Dilated-pupil acquisition
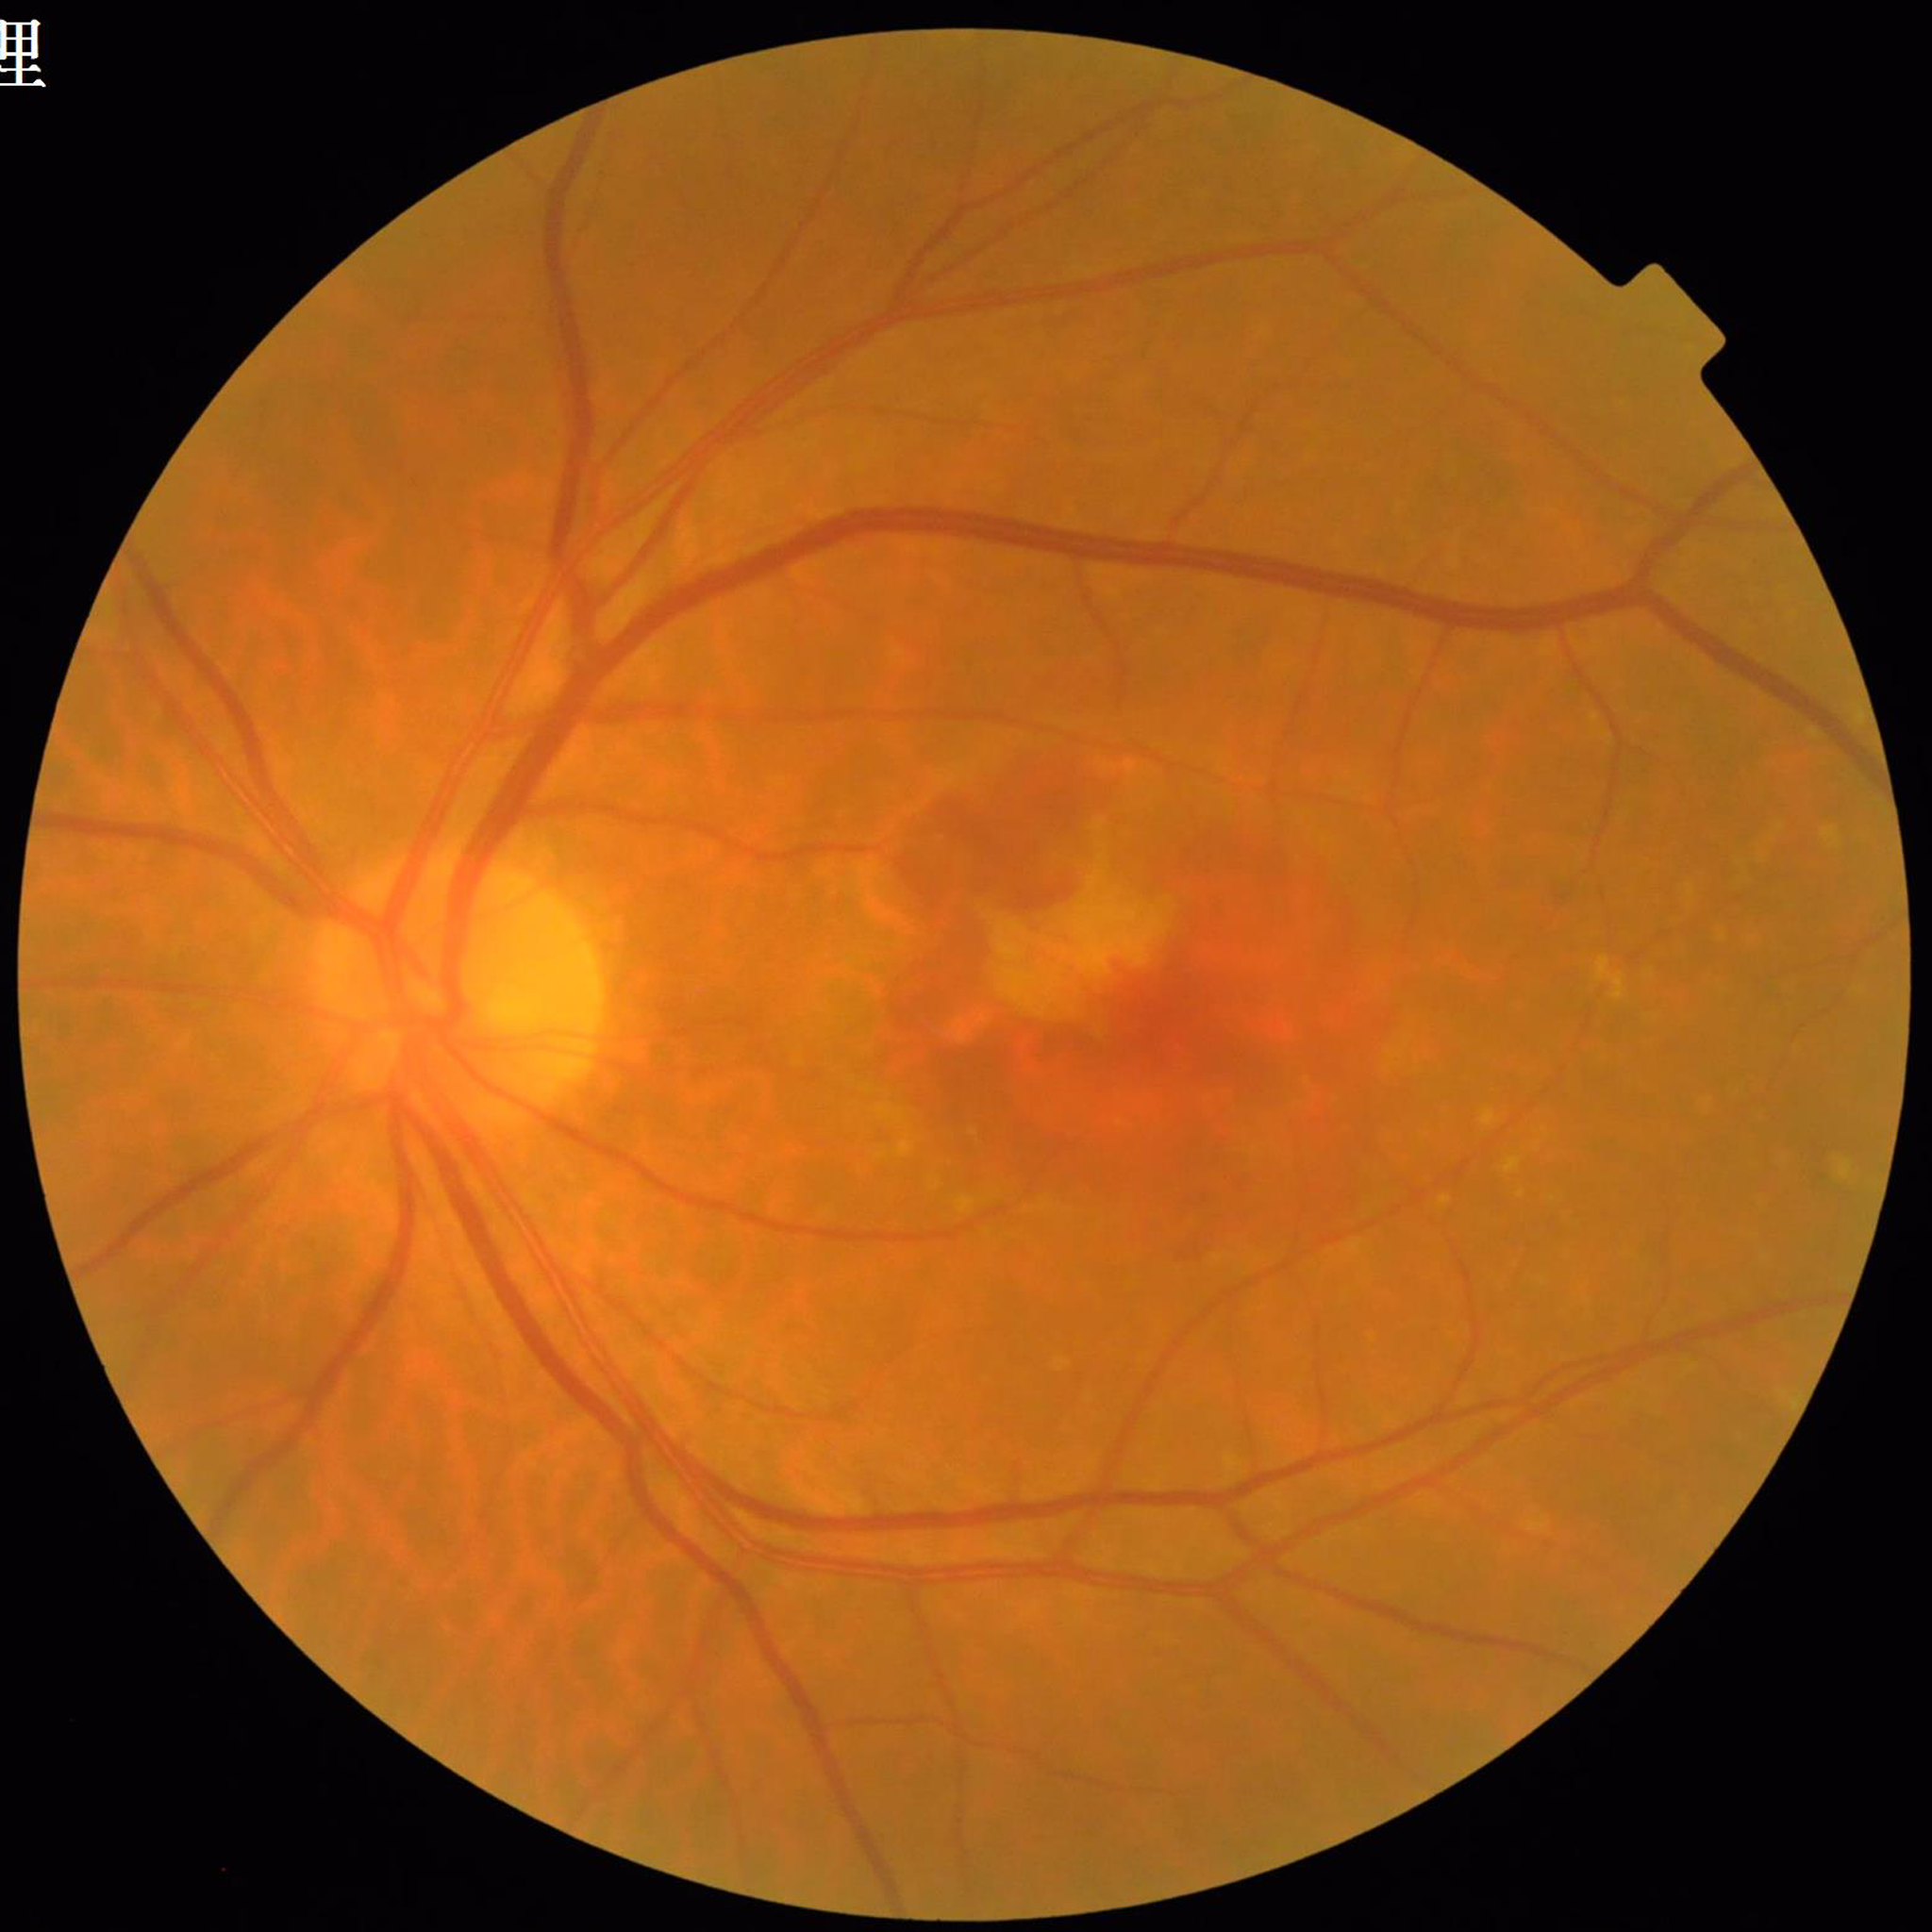
Quality: adequate. Color fundus photo. Patient diagnosed with age-related macular degeneration.